Infant wide-field fundus photograph — 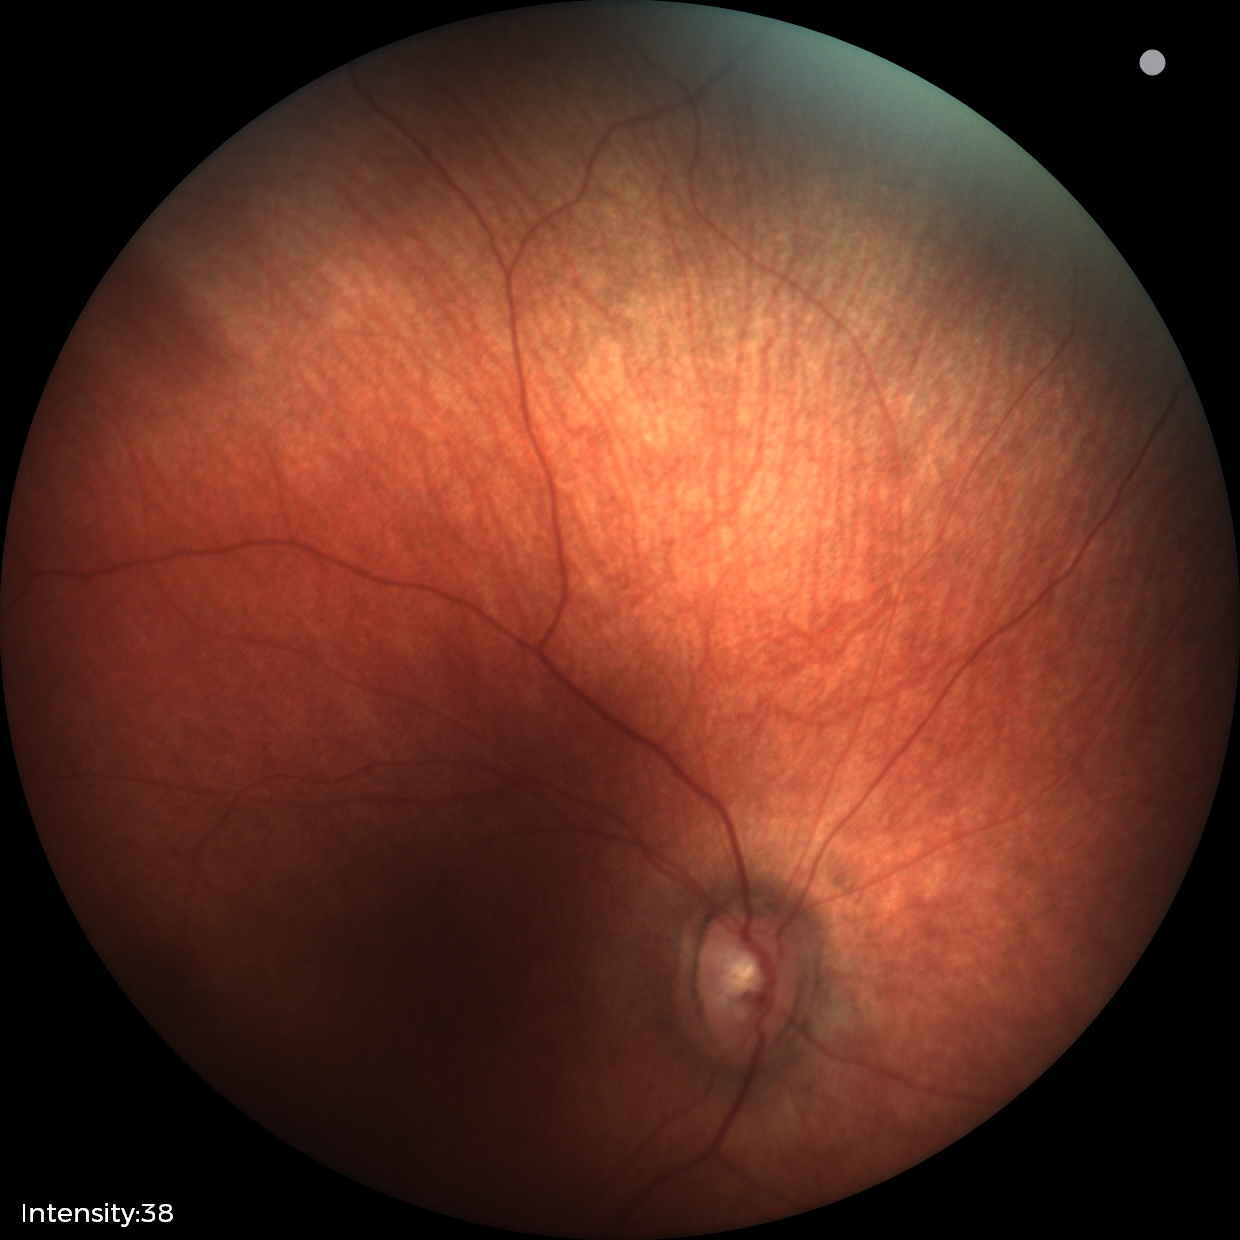
No retinal pathology identified on screening.